2048 x 1536 pixels: 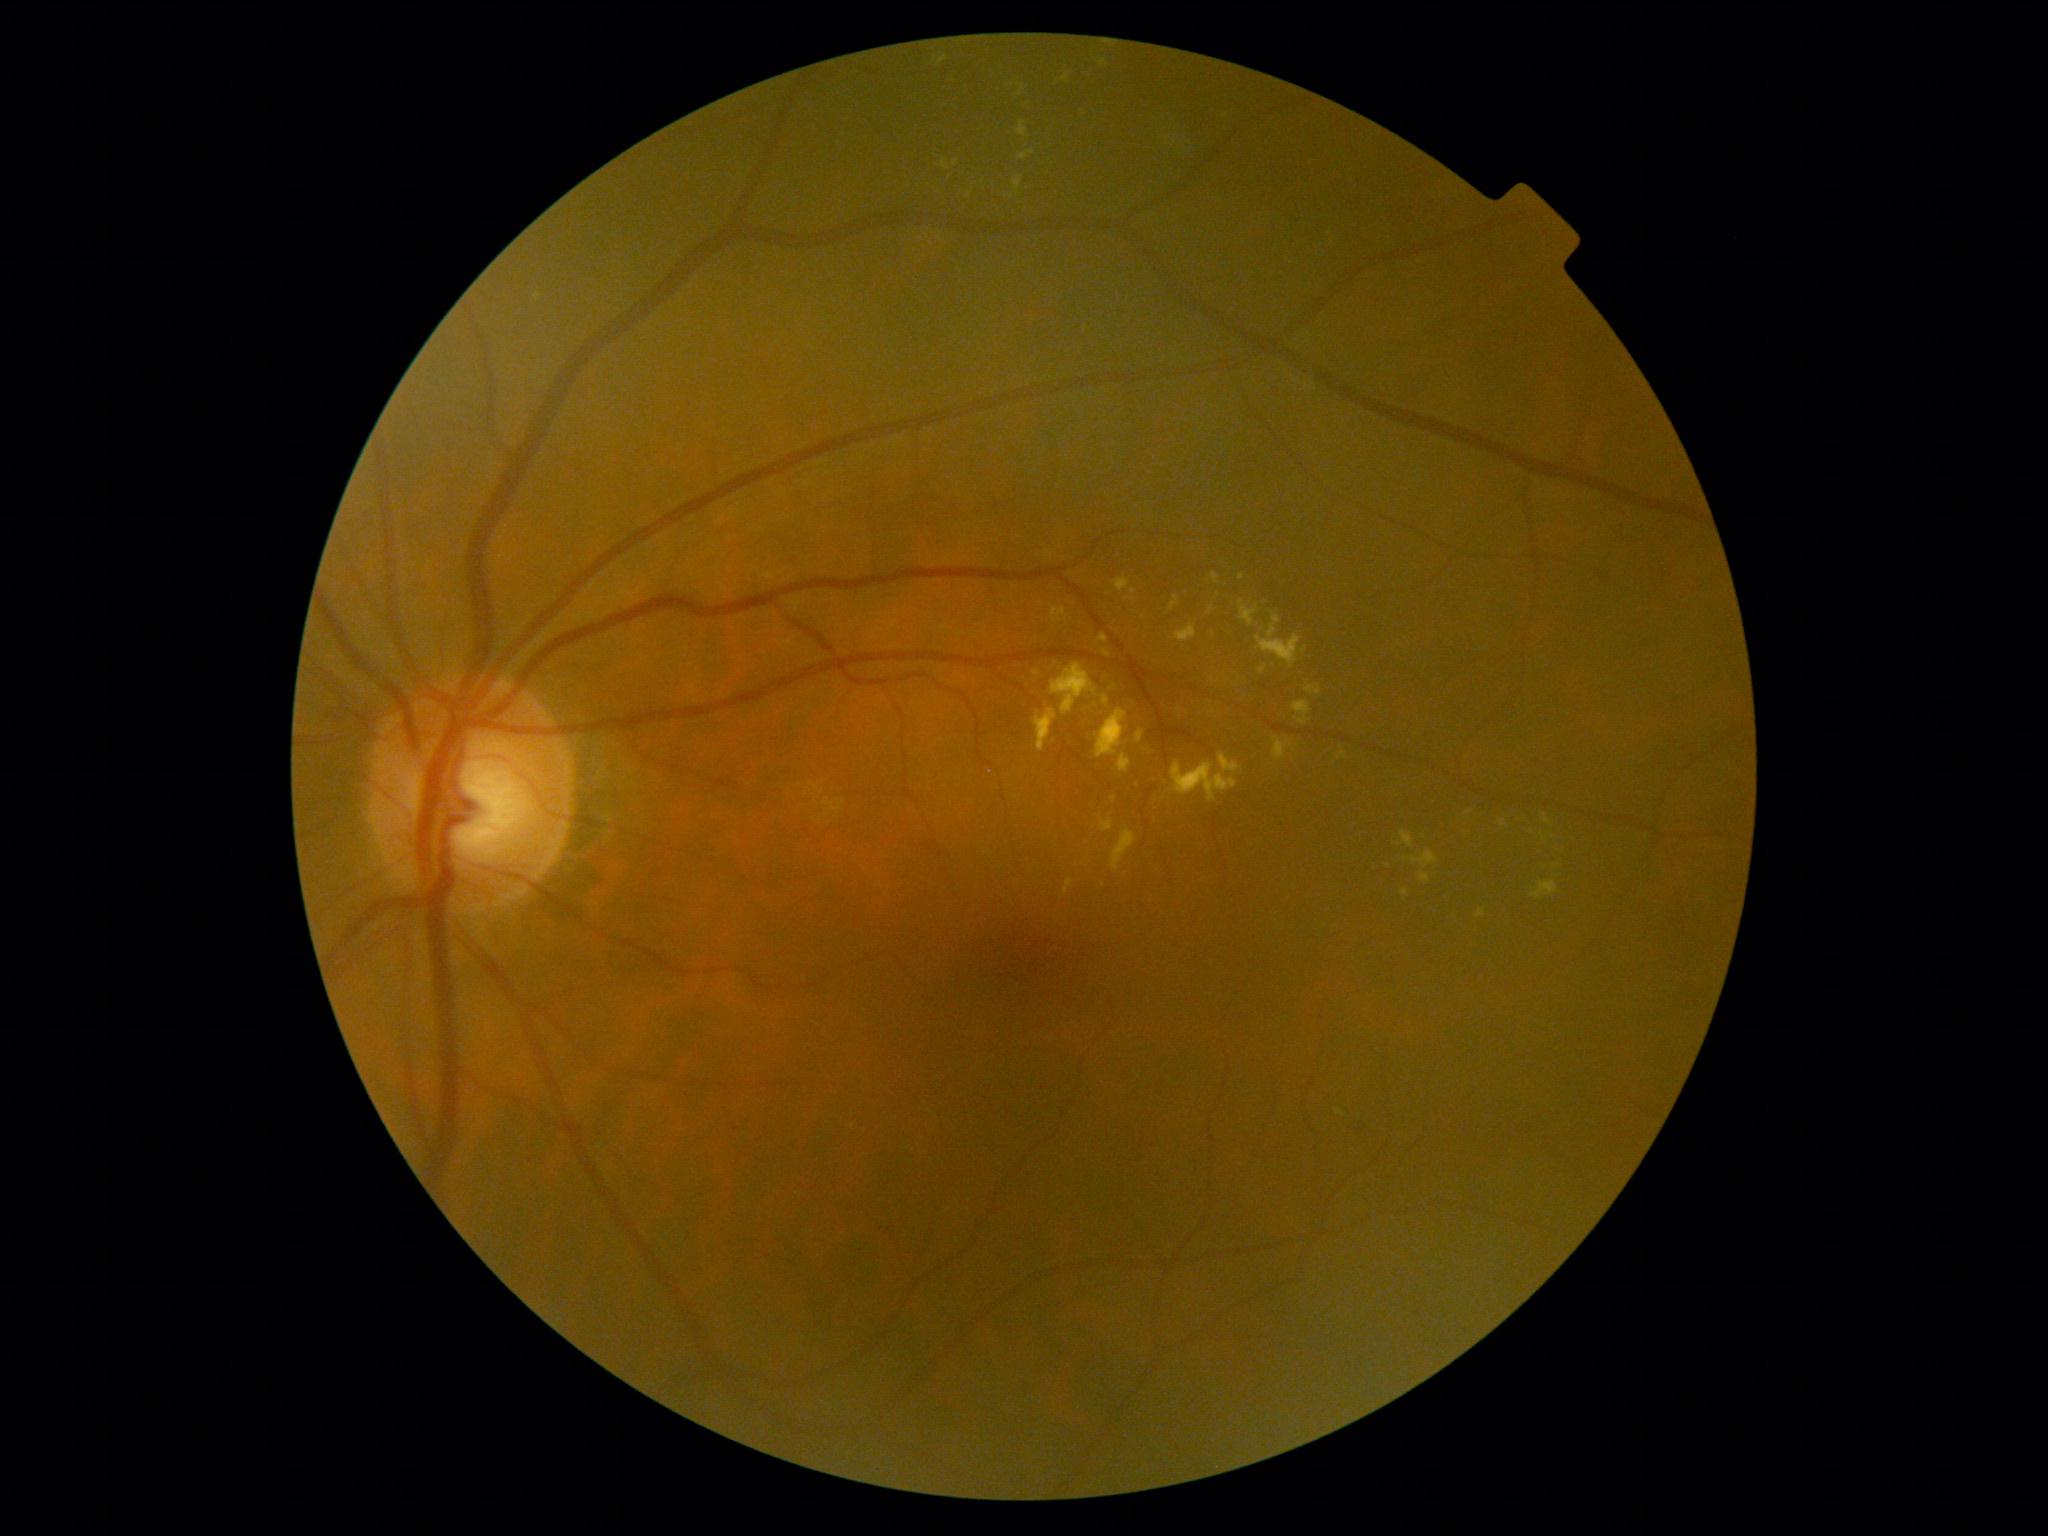

Diabetic retinopathy (DR): moderate non-proliferative diabetic retinopathy (grade 2); non-proliferative diabetic retinopathy
Selected lesions:
hard exudates (EXs) (more not shown) = x1=1096, y1=709, x2=1127, y2=759 | x1=1239, y1=601, x2=1259, y2=627 | x1=1136, y1=732, x2=1145, y2=743 | x1=1099, y1=60, x2=1109, y2=67 | x1=1337, y1=752, x2=1347, y2=760 | x1=1061, y1=73, x2=1070, y2=85 | x1=1113, y1=578, x2=1130, y2=593 | x1=1100, y1=819, x2=1113, y2=834 | x1=1175, y1=624, x2=1198, y2=643 | x1=1307, y1=687, x2=1322, y2=696
Smaller EXs around 1114:800 | 1399:844 | 1213:713 | 1503:824 | 1469:813